45° field of view.
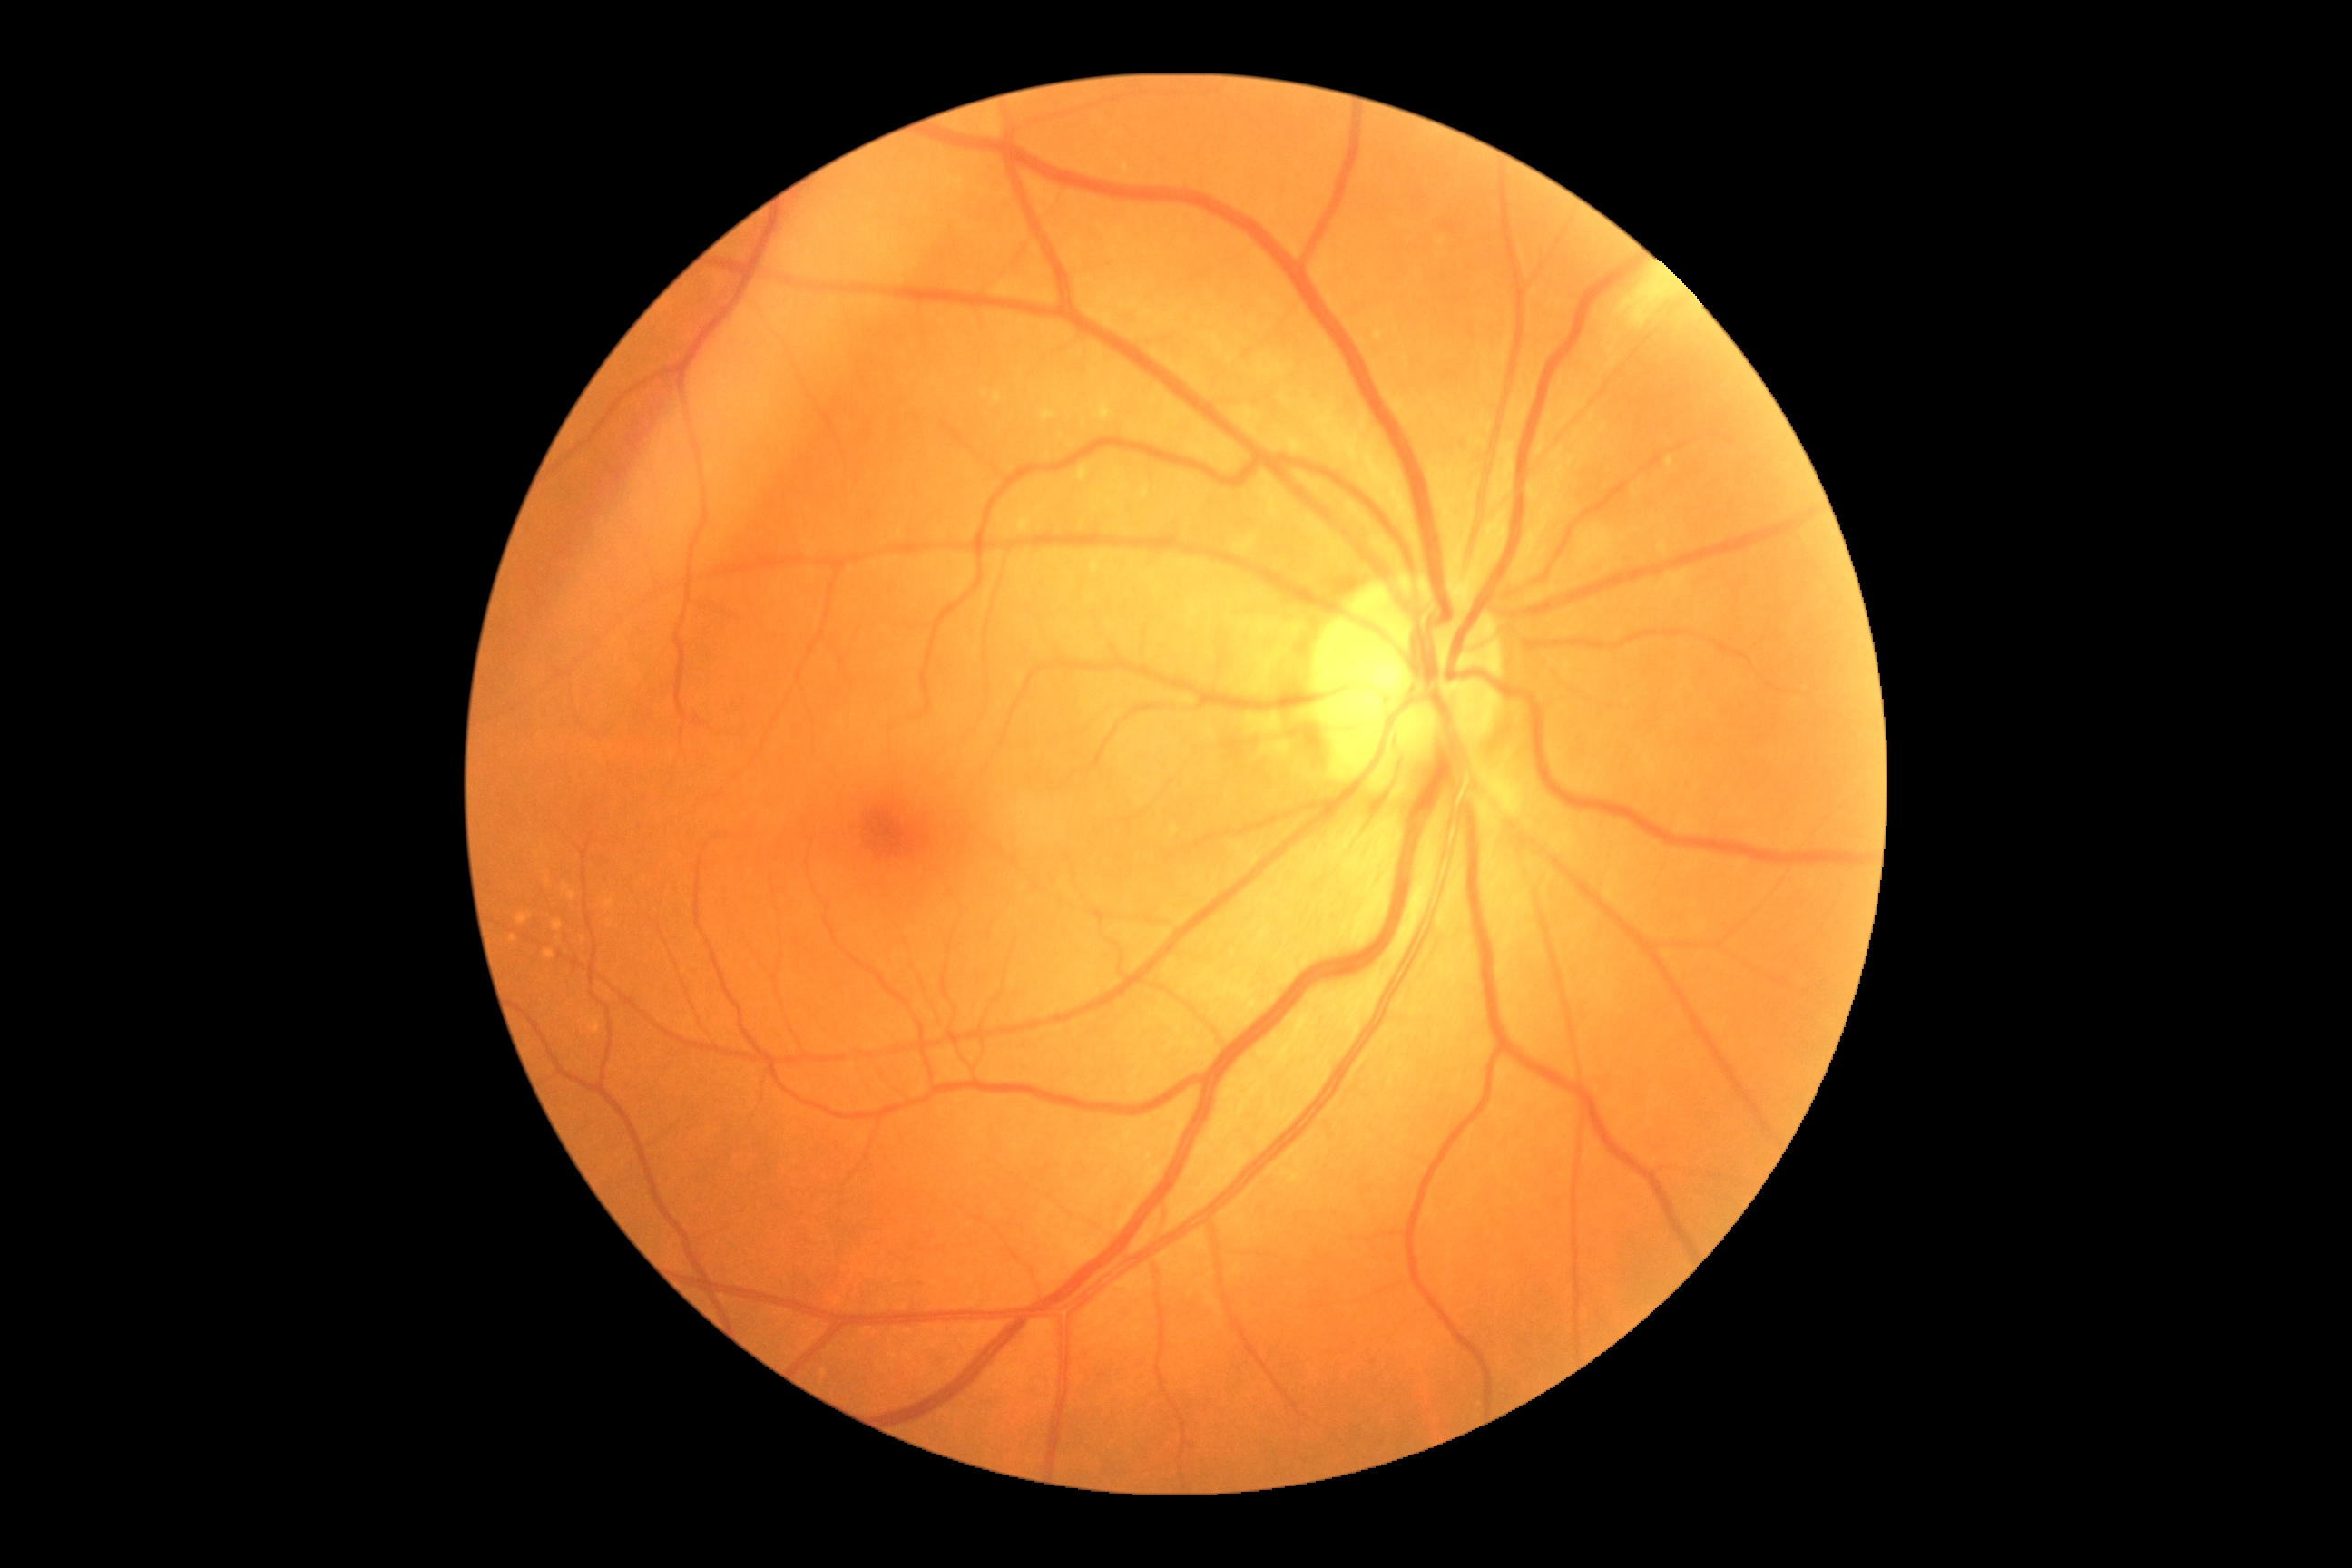
Annotations:
• DR: no apparent diabetic retinopathy (grade 0)
• DR impression: no DR findings